Nonmydriatic fundus photograph, posterior pole photograph, 848x848px — 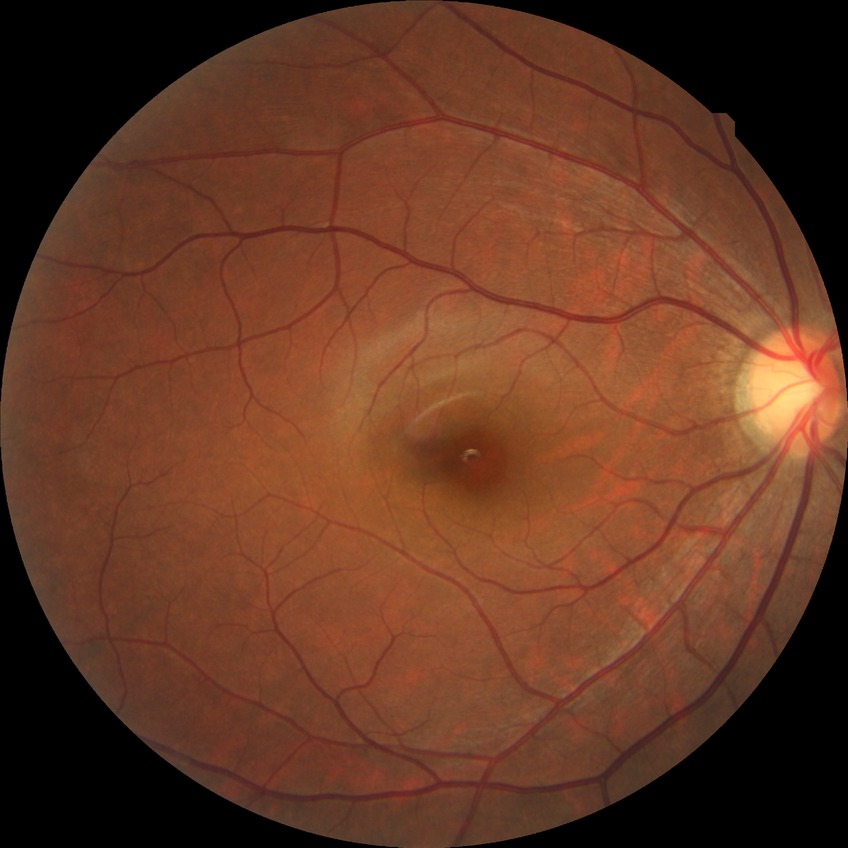

diabetic retinopathy (DR): no diabetic retinopathy (NDR).